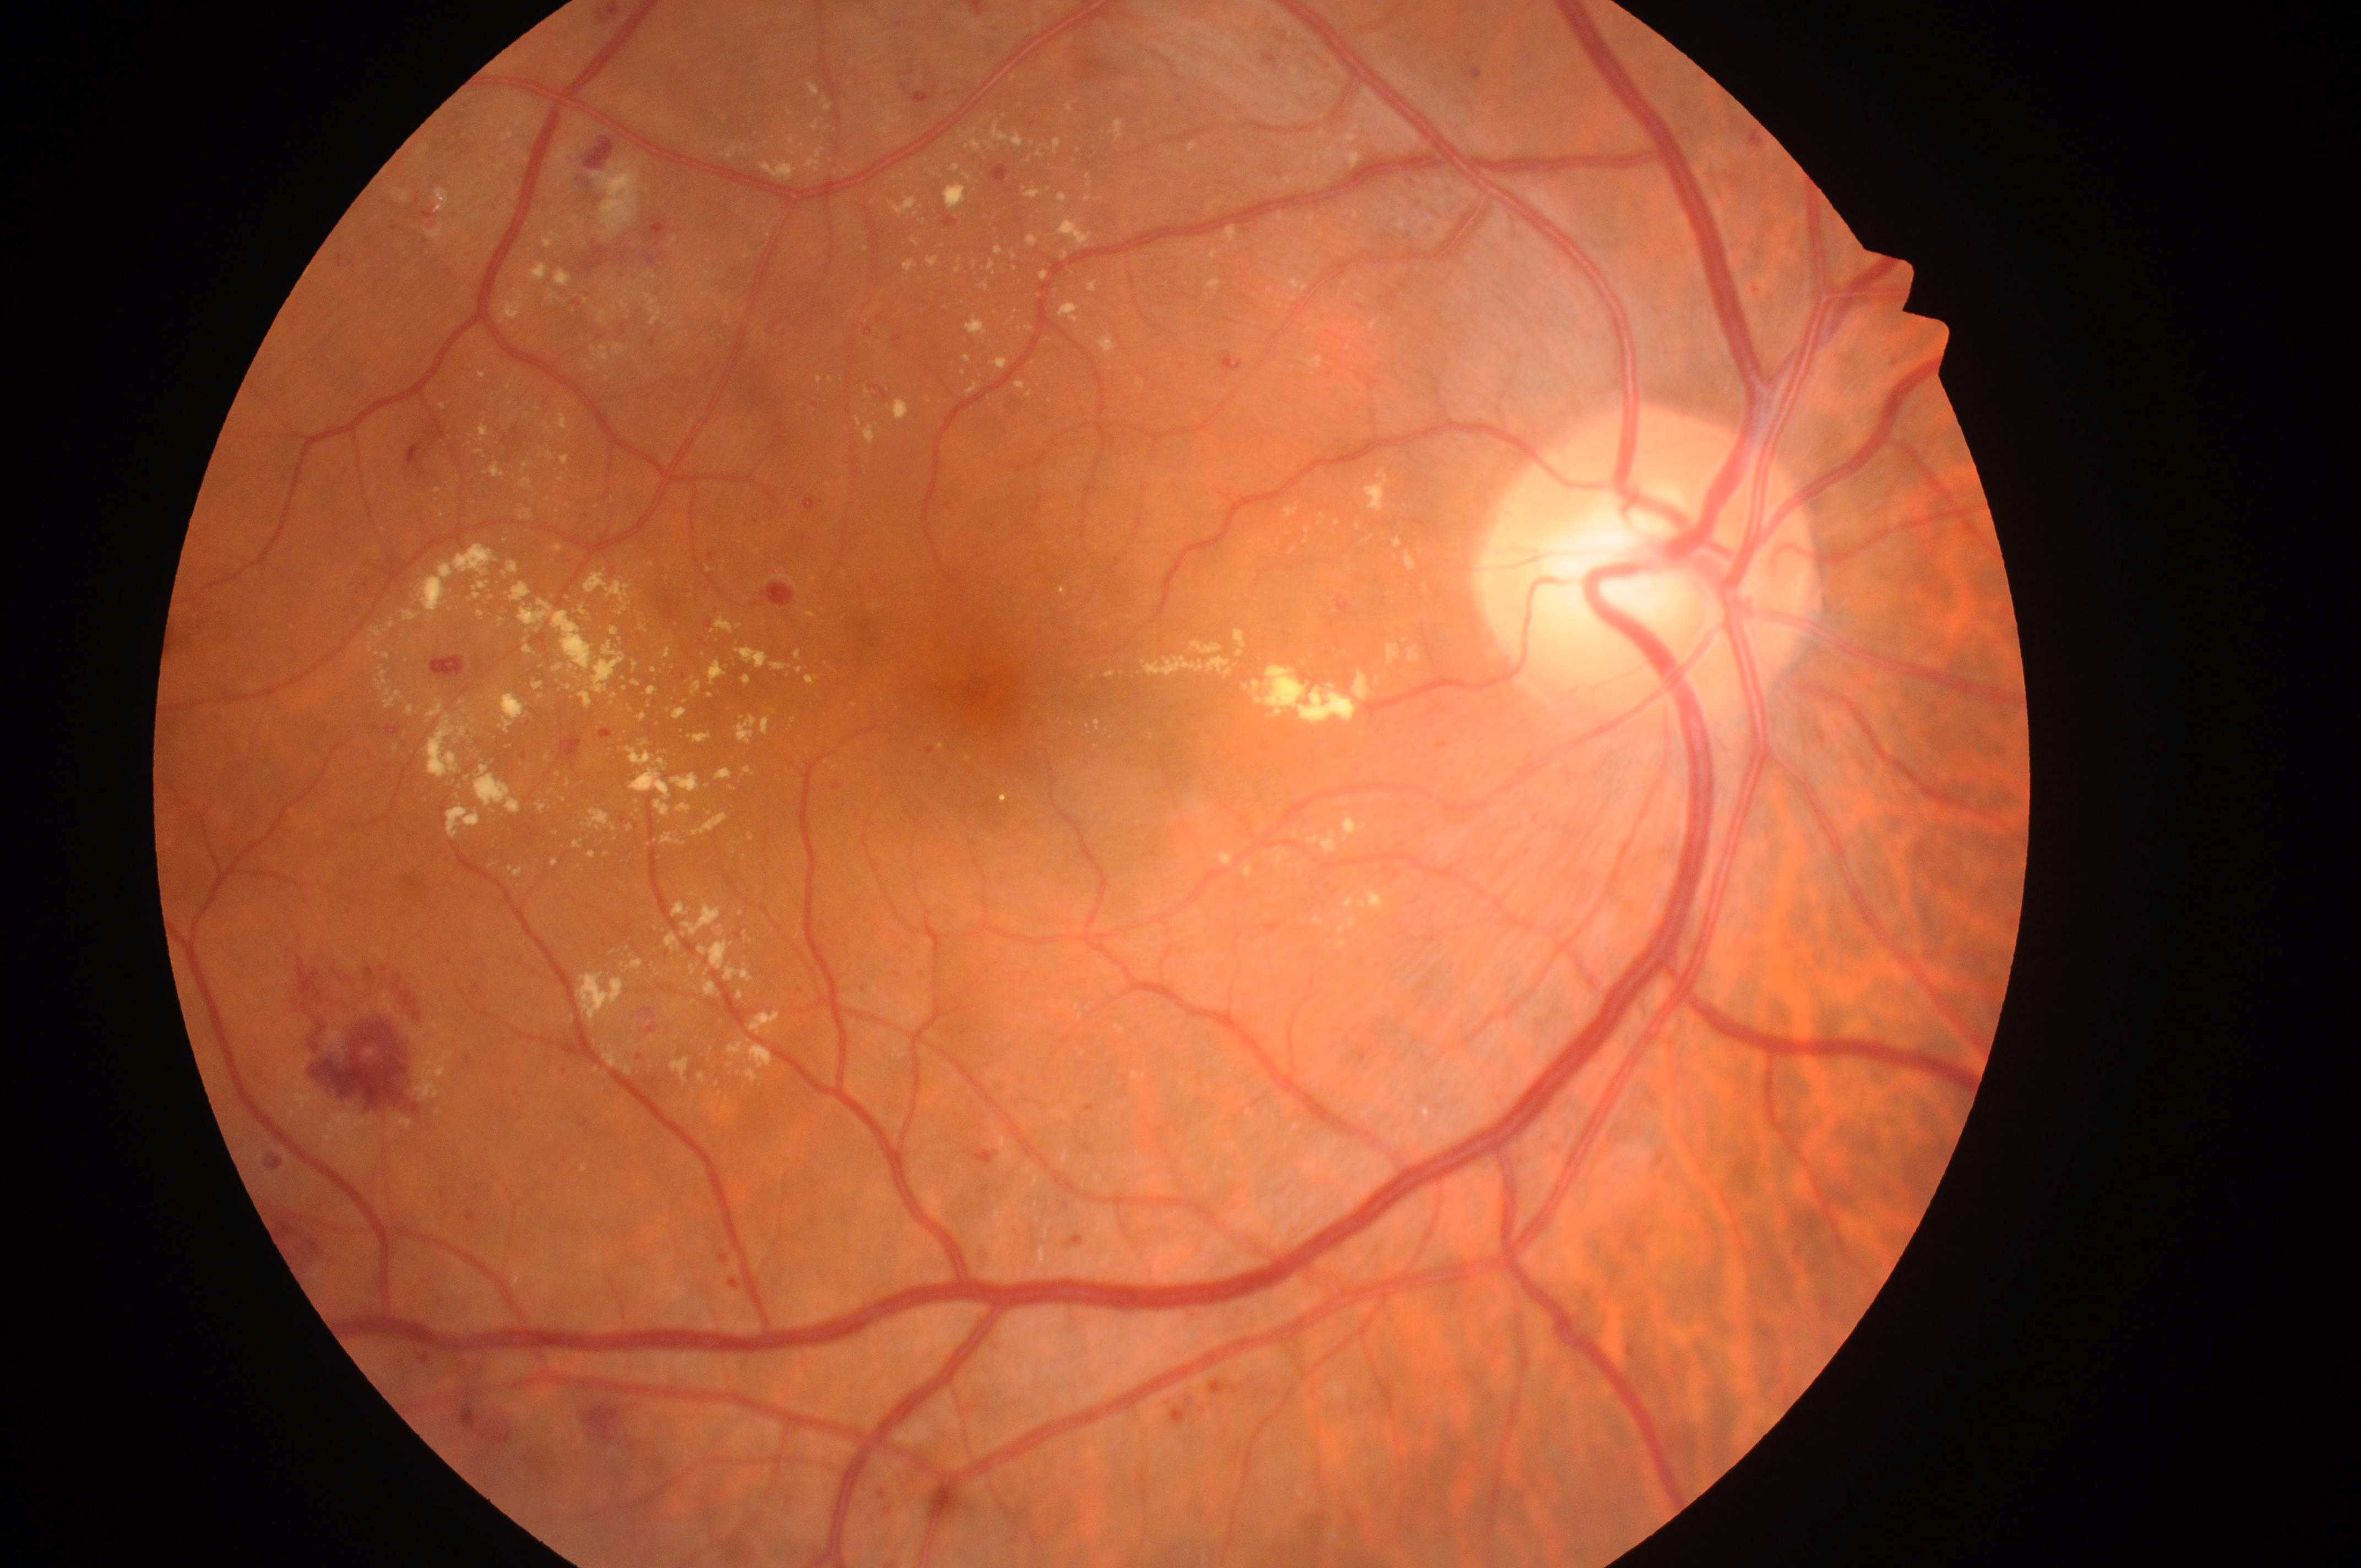
Annotations:
• macula center · (x=988, y=687)
• DR severity · grade 3 (severe NPDR) — more than 20 intraretinal hemorrhages in each of 4 quadrants, definite venous beading in 2 or more quadrants, or prominent intraretinal microvascular abnormalities in 1 or more quadrants, with no signs of proliferative retinopathy
• laterality · the right eye
• ONH · (x=1646, y=581)
• DME risk · grade 2 (high risk) — hard exudates within one disc diameter of the macula center